45-degree field of view; 2352 x 1568 pixels — 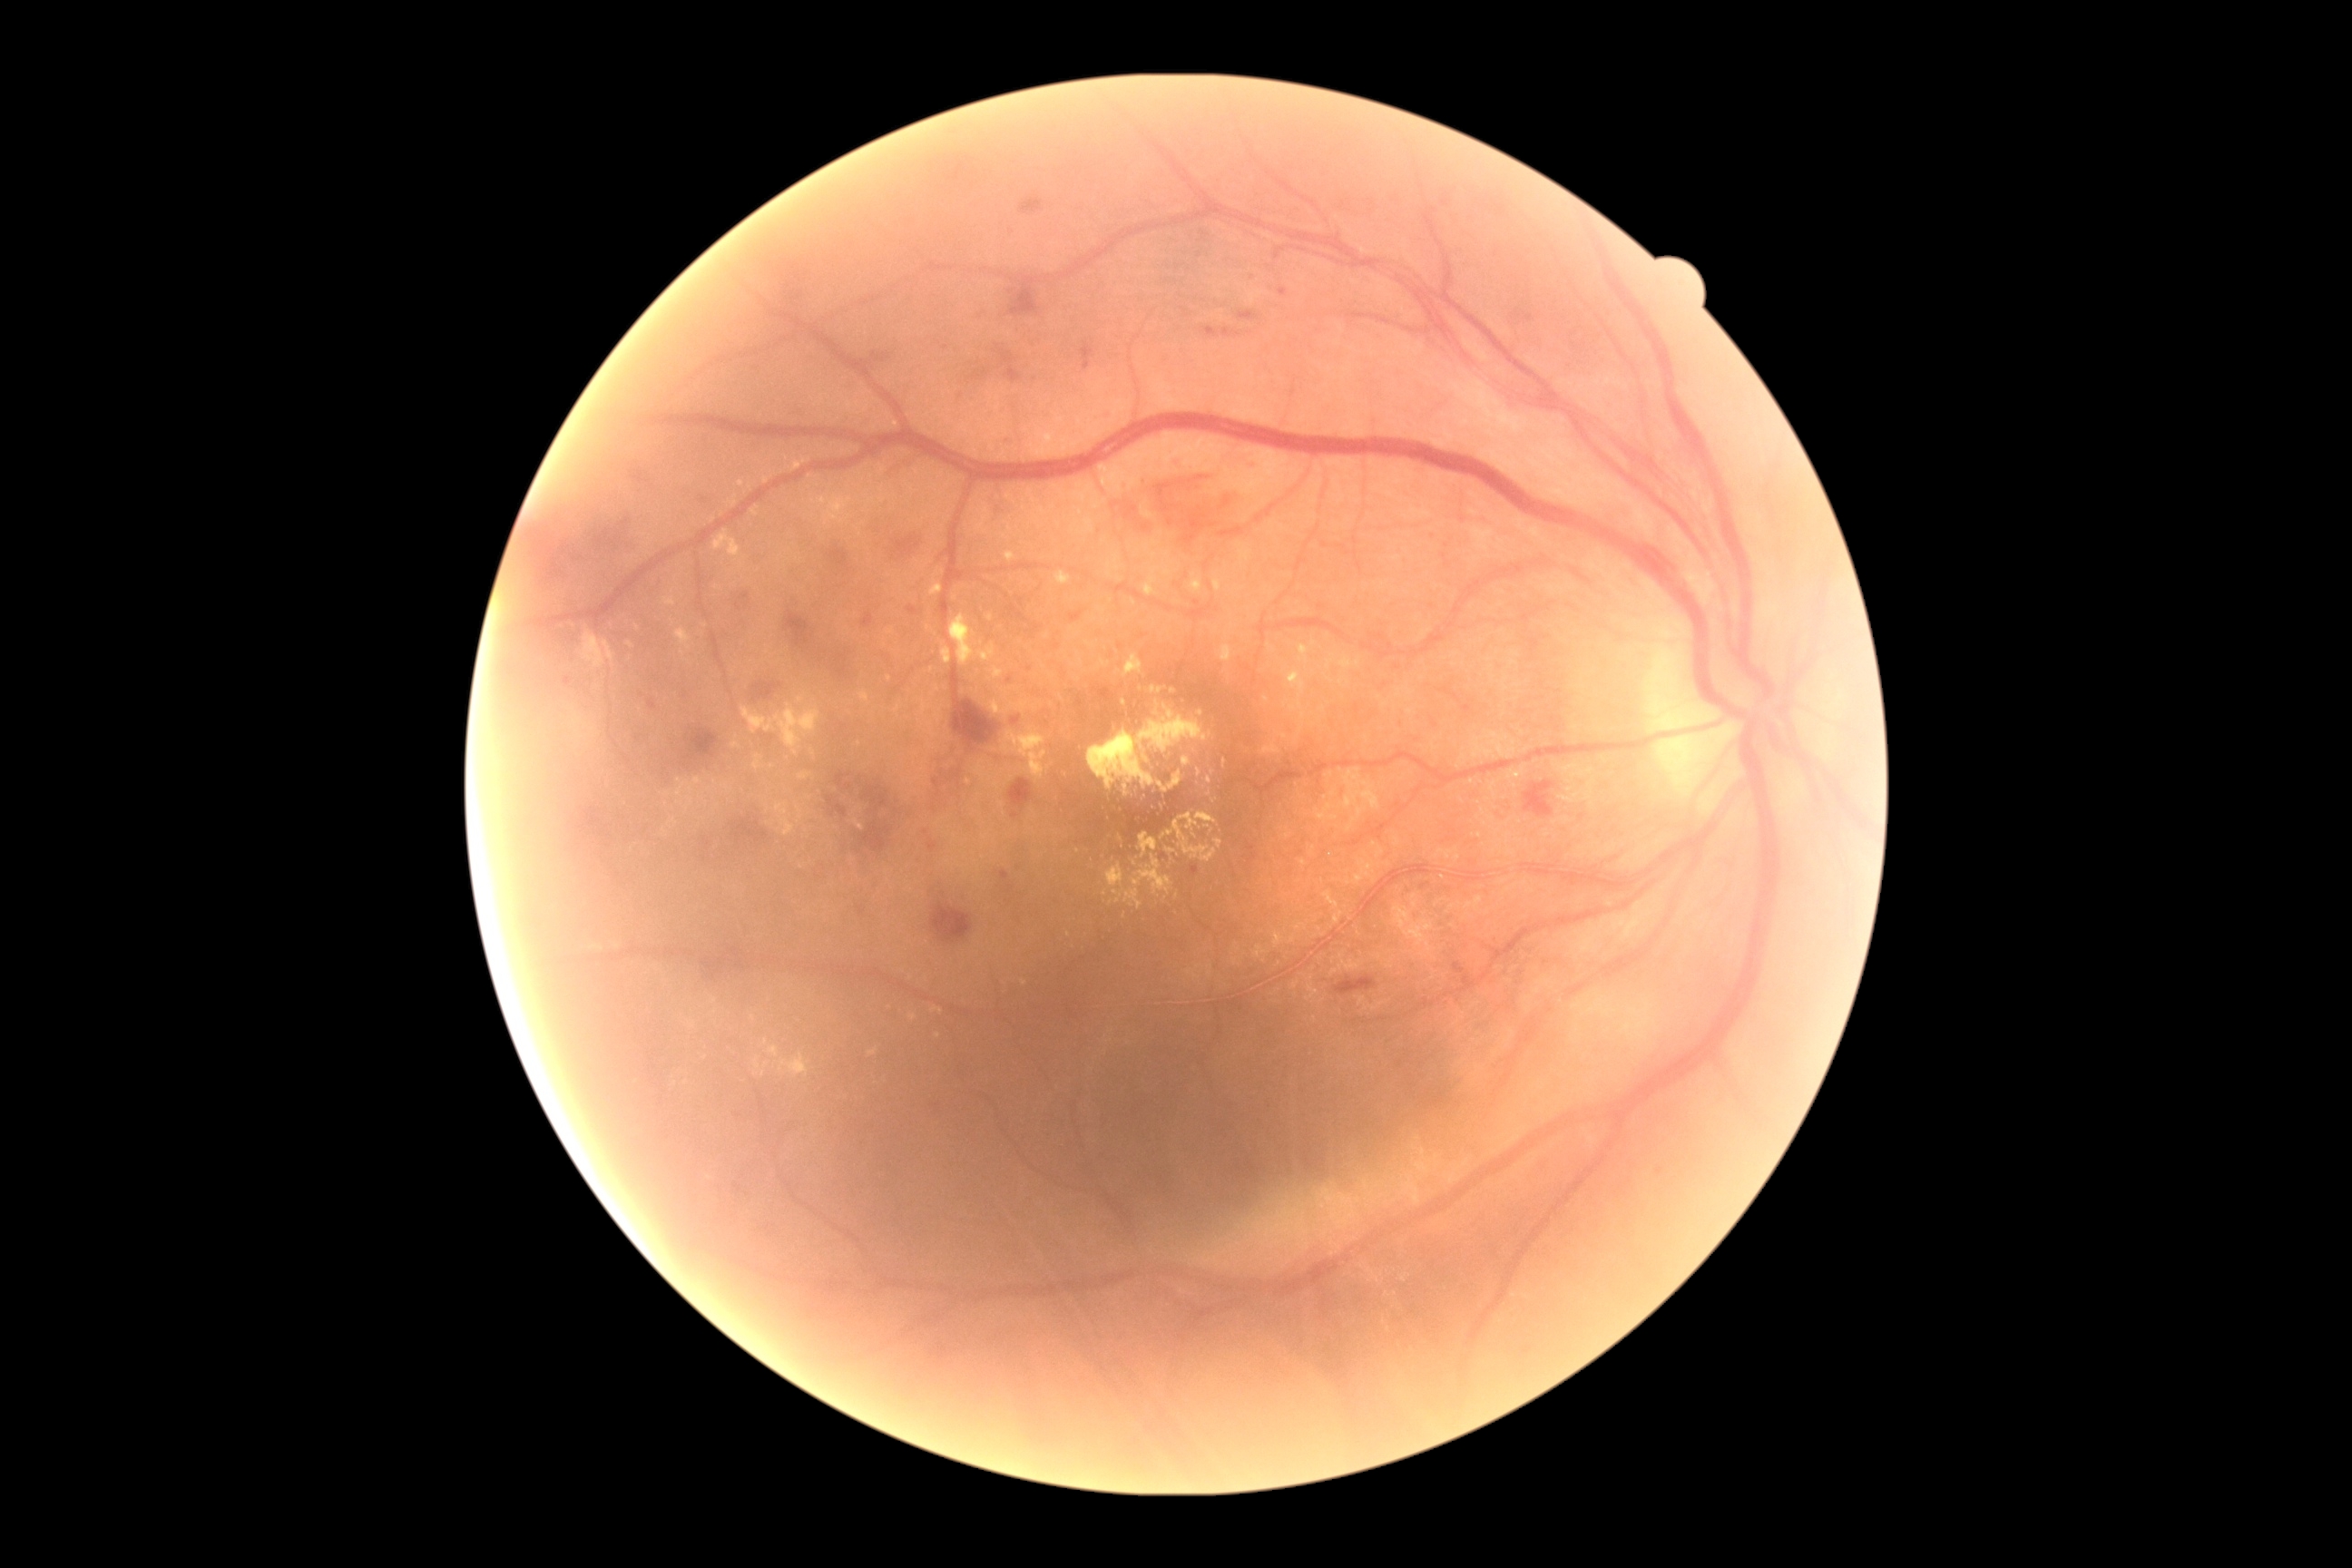
DR severity is grade 2
A subset of detected lesions:
HEs (subset) = 1081, 344, 1095, 371; 1525, 783, 1563, 830; 839, 656, 848, 662; 839, 667, 848, 678; 952, 694, 999, 750; 1014, 716, 1021, 725; 785, 611, 810, 647; 1455, 965, 1469, 986; 894, 536, 921, 560; 696, 950, 730, 988; 1115, 466, 1235, 544; 863, 614, 874, 627; 754, 681, 781, 700
Additional small HEs near (1012,292)
EXs (subset) = 977, 645, 995, 663; 732, 743, 740, 749; 1197, 812, 1213, 823; 910, 1015, 917, 1023; 689, 778, 701, 794; 741, 705, 821, 756; 1213, 580, 1222, 591; 689, 1021, 696, 1030; 1291, 925, 1302, 937; 1159, 772, 1184, 794; 1280, 734, 1288, 740; 812, 496, 852, 525
Additional small EXs near (933,735); (1214,801); (754,1019); (638,628); (1119,672); (766,1042)